No pharmacologic dilation: 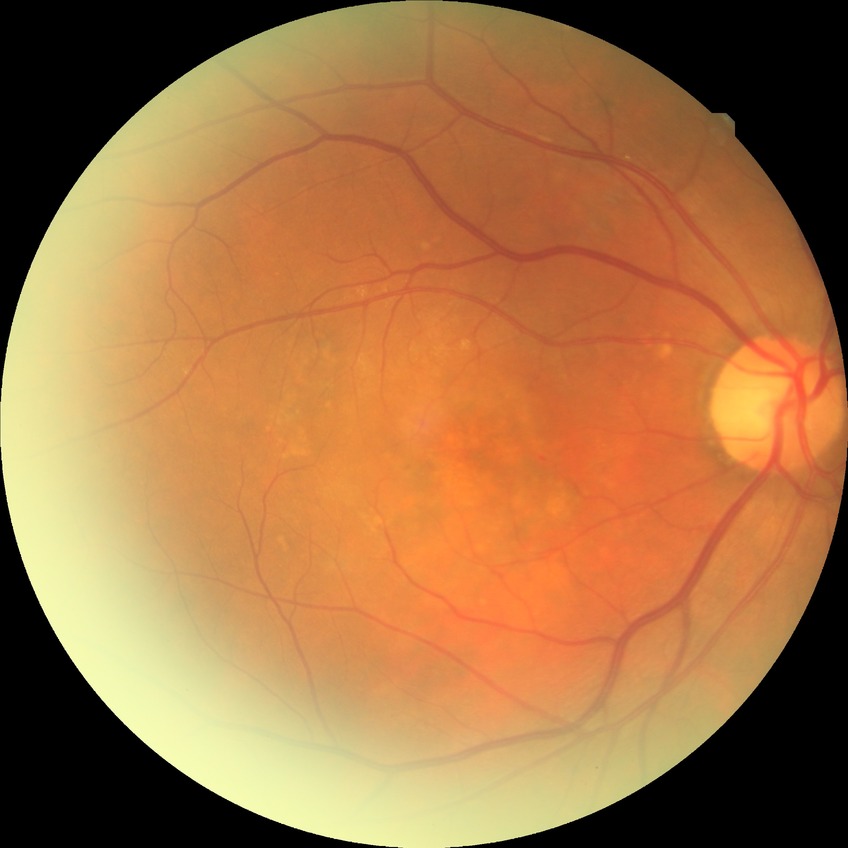 diabetic retinopathy stage: no diabetic retinopathy.